Camera: Nidek AFC-330 — 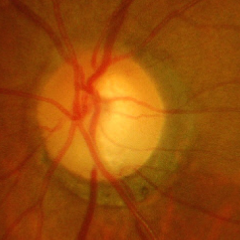

Q: Glaucoma assessment?
A: Advanced glaucoma.